2352x1568; retinal fundus photograph; FOV: 45 degrees — 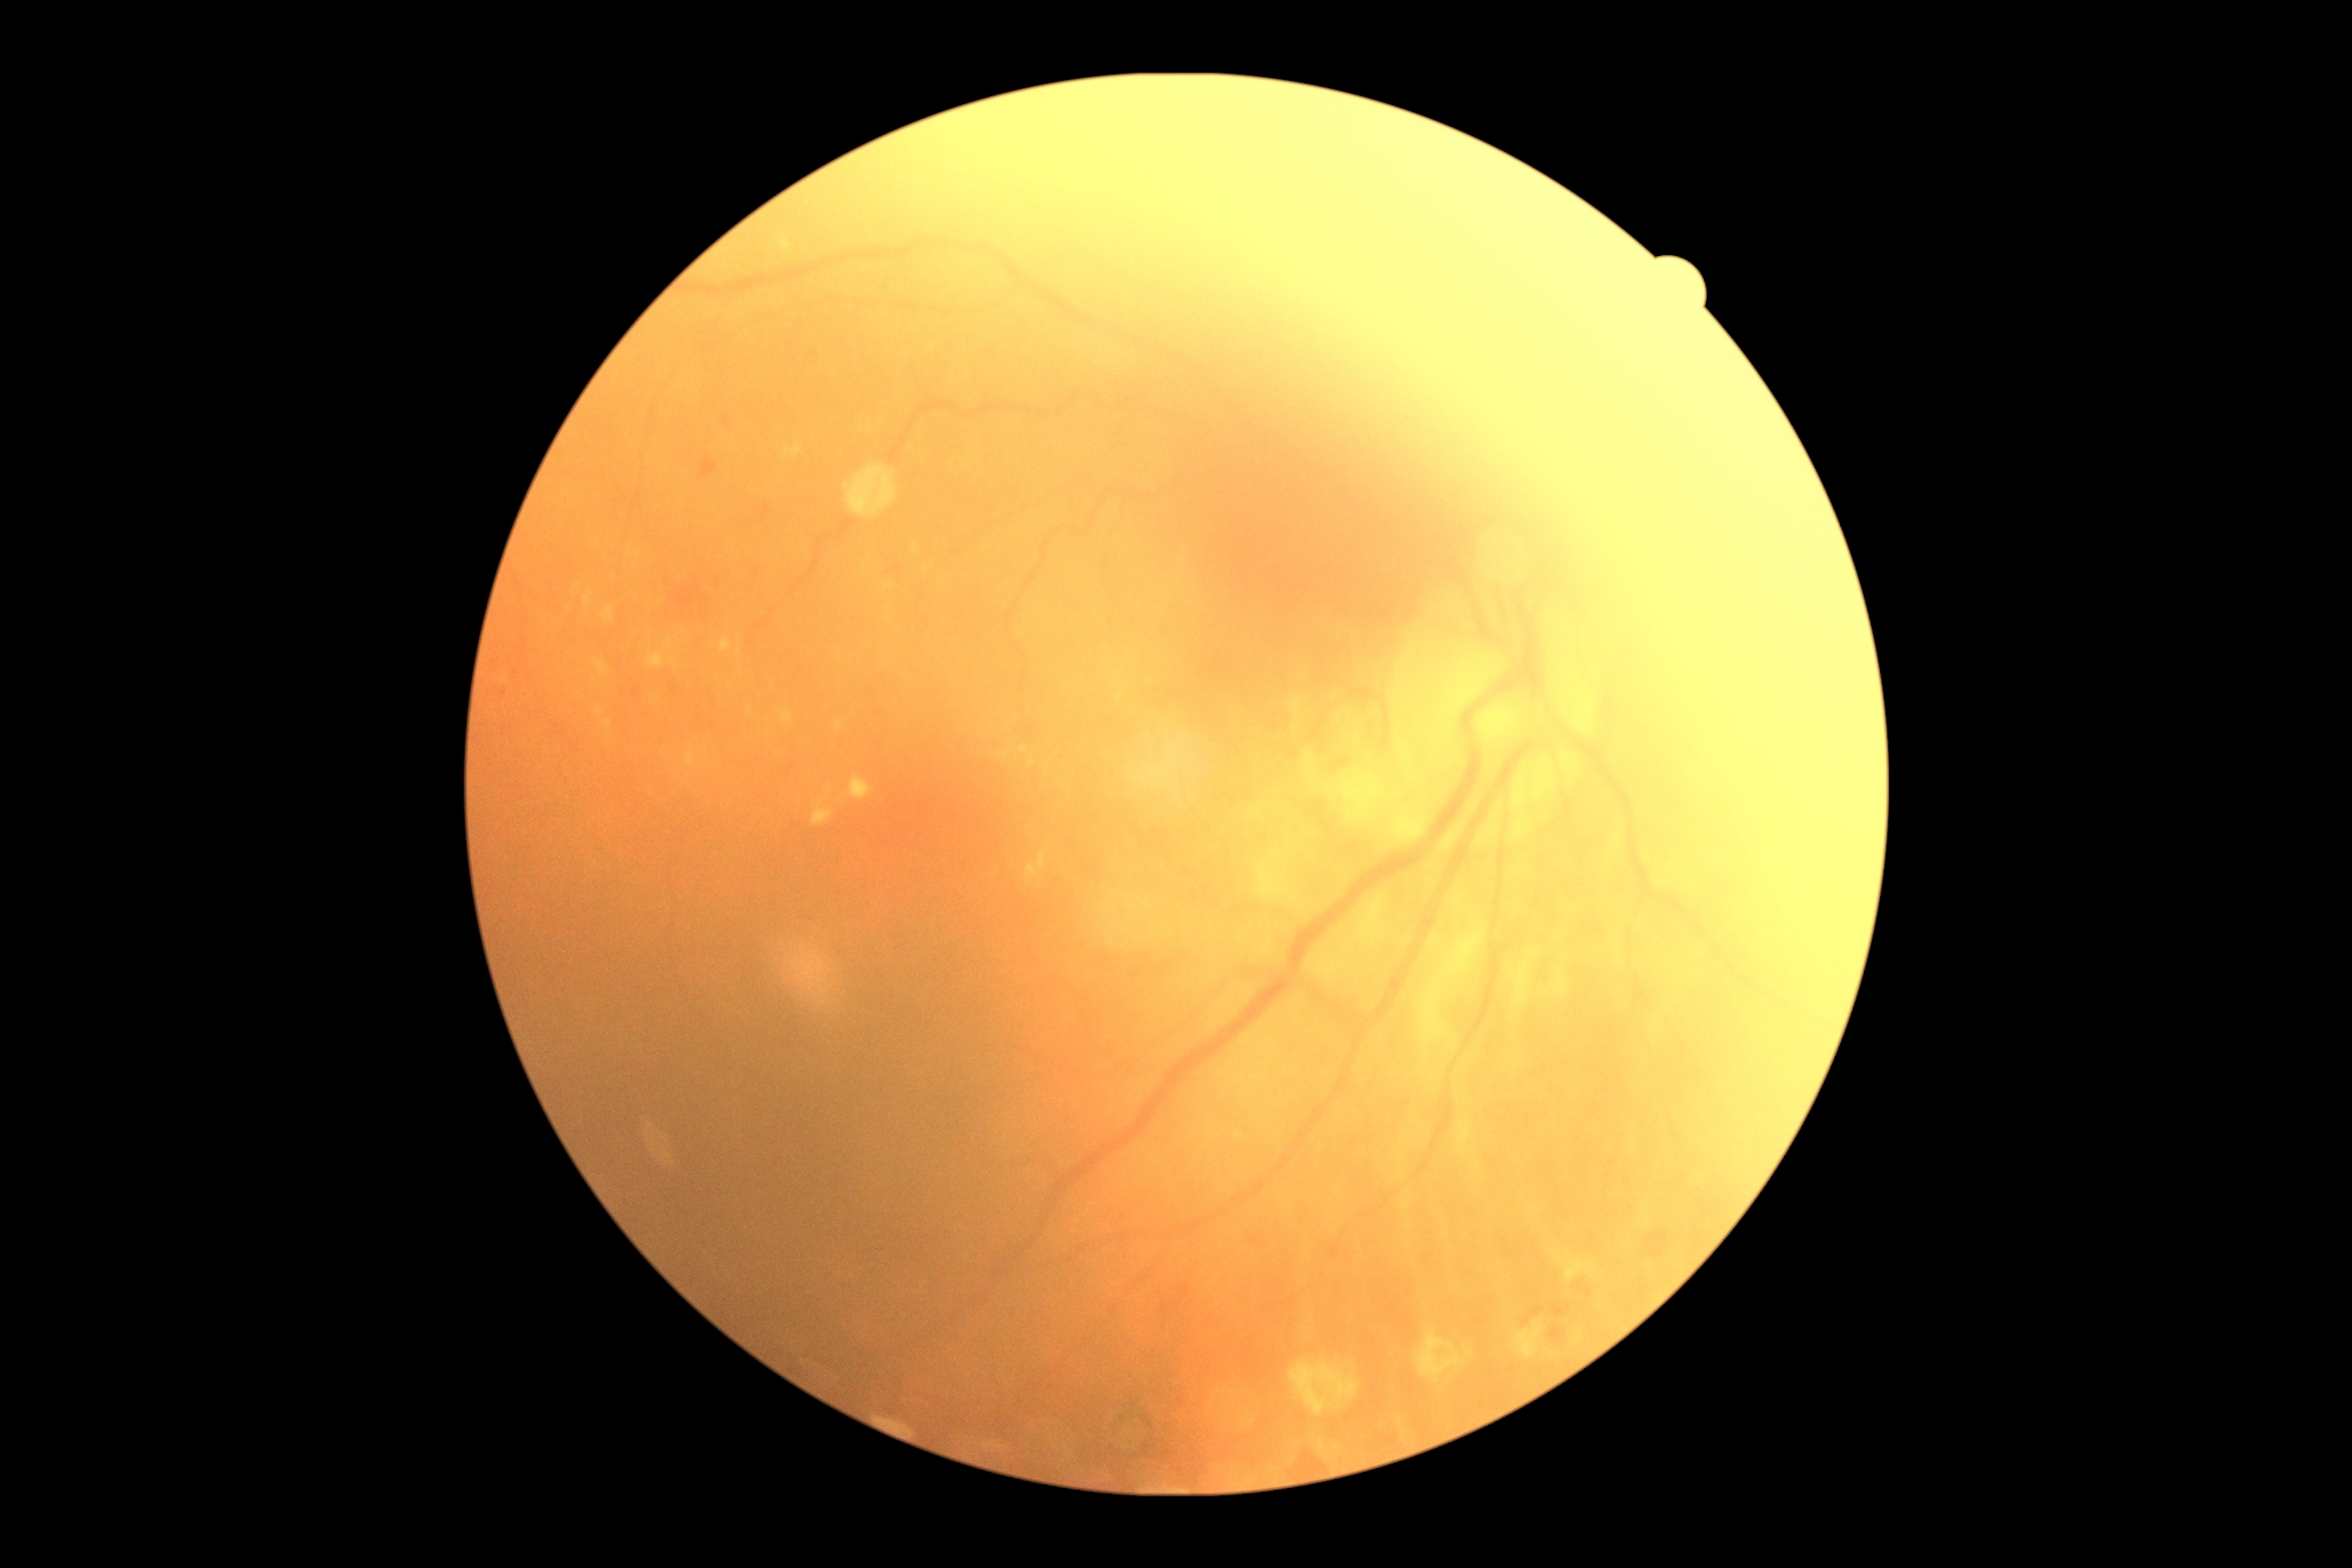
Diabetic retinopathy (DR): 2 — more than just microaneurysms but less than severe NPDR.